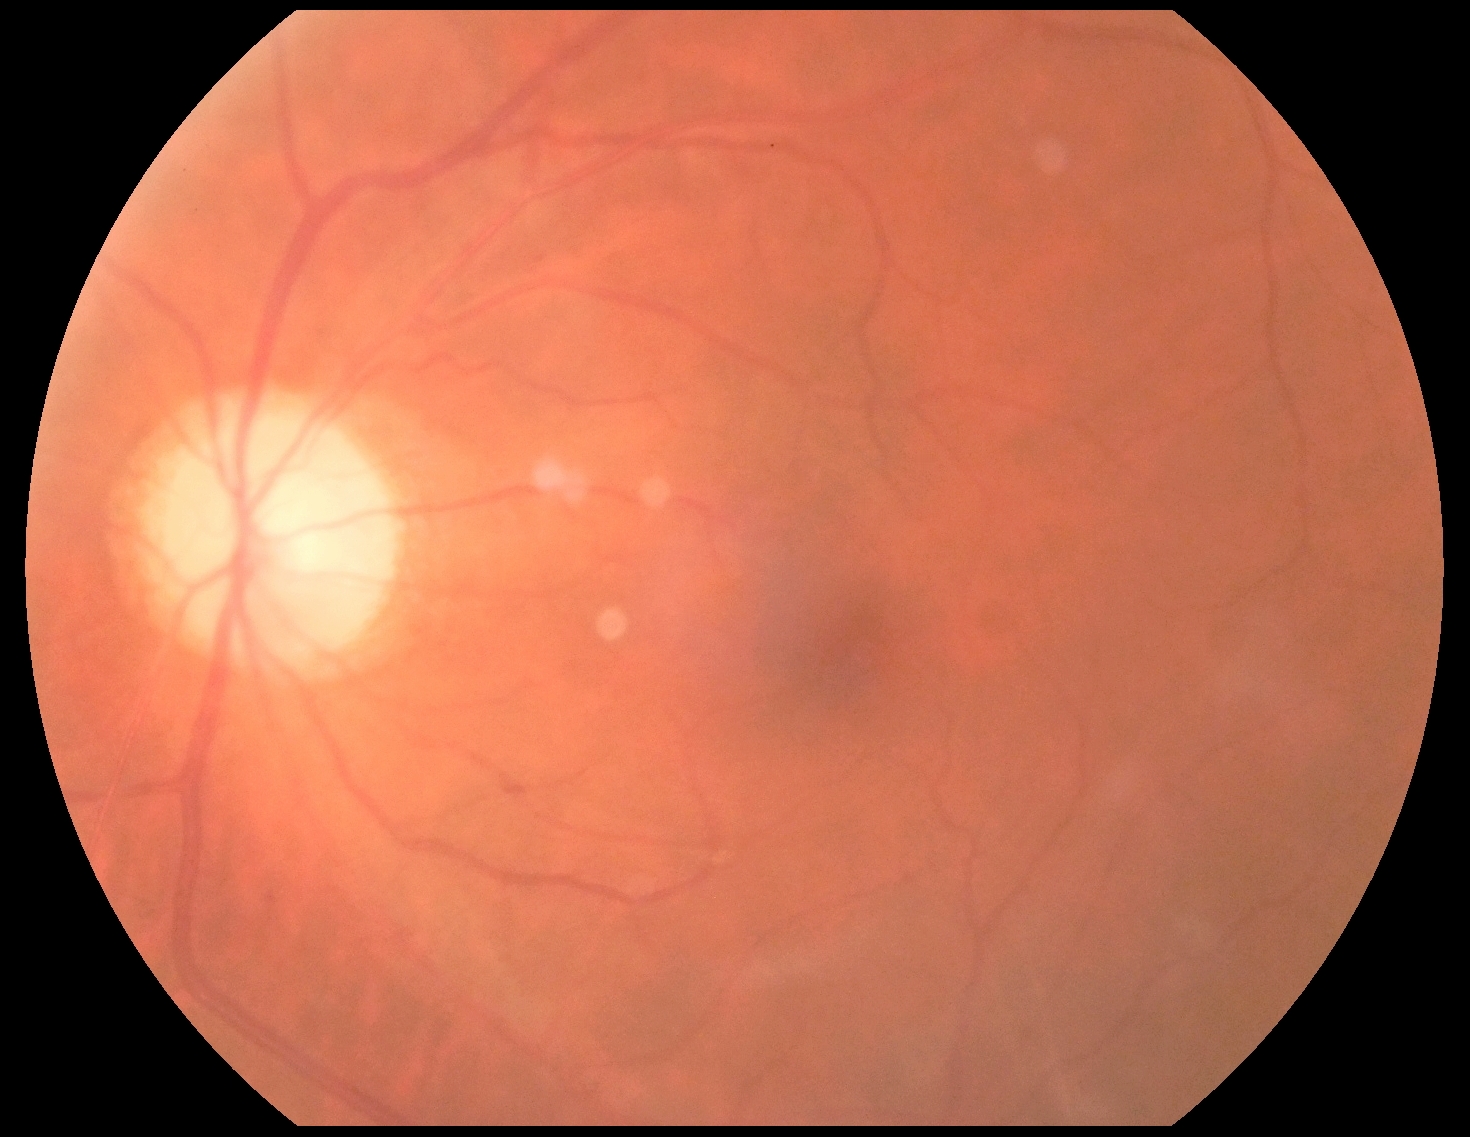
Retinopathy grade is 0 (no apparent retinopathy).